Modified Davis grading
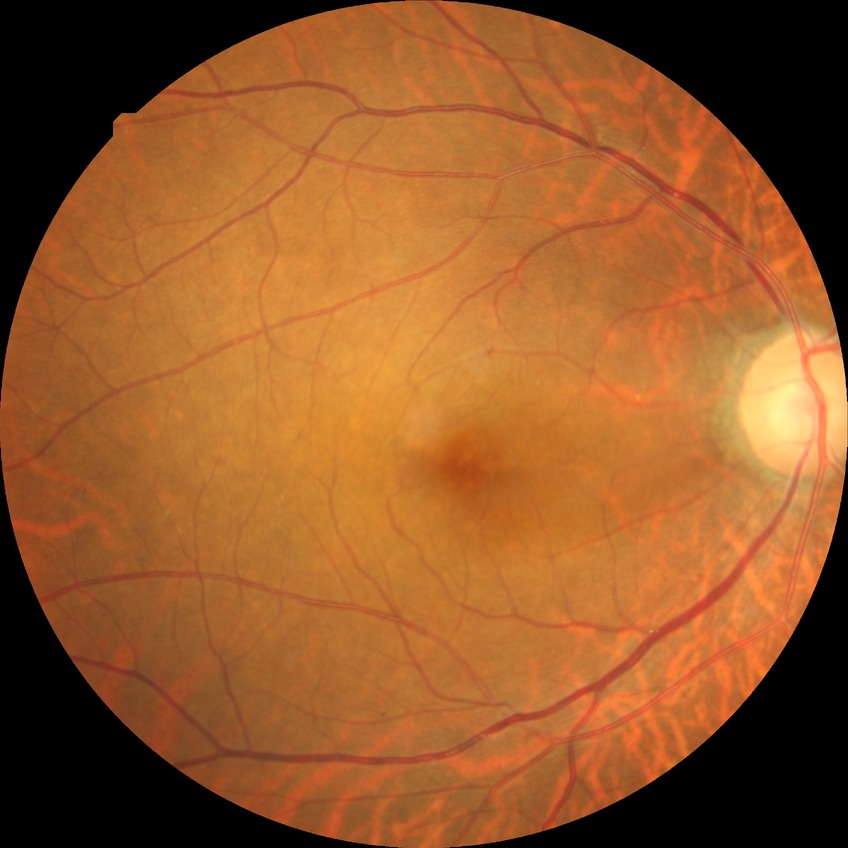
Diabetic retinopathy (DR) is SDR (simple diabetic retinopathy).